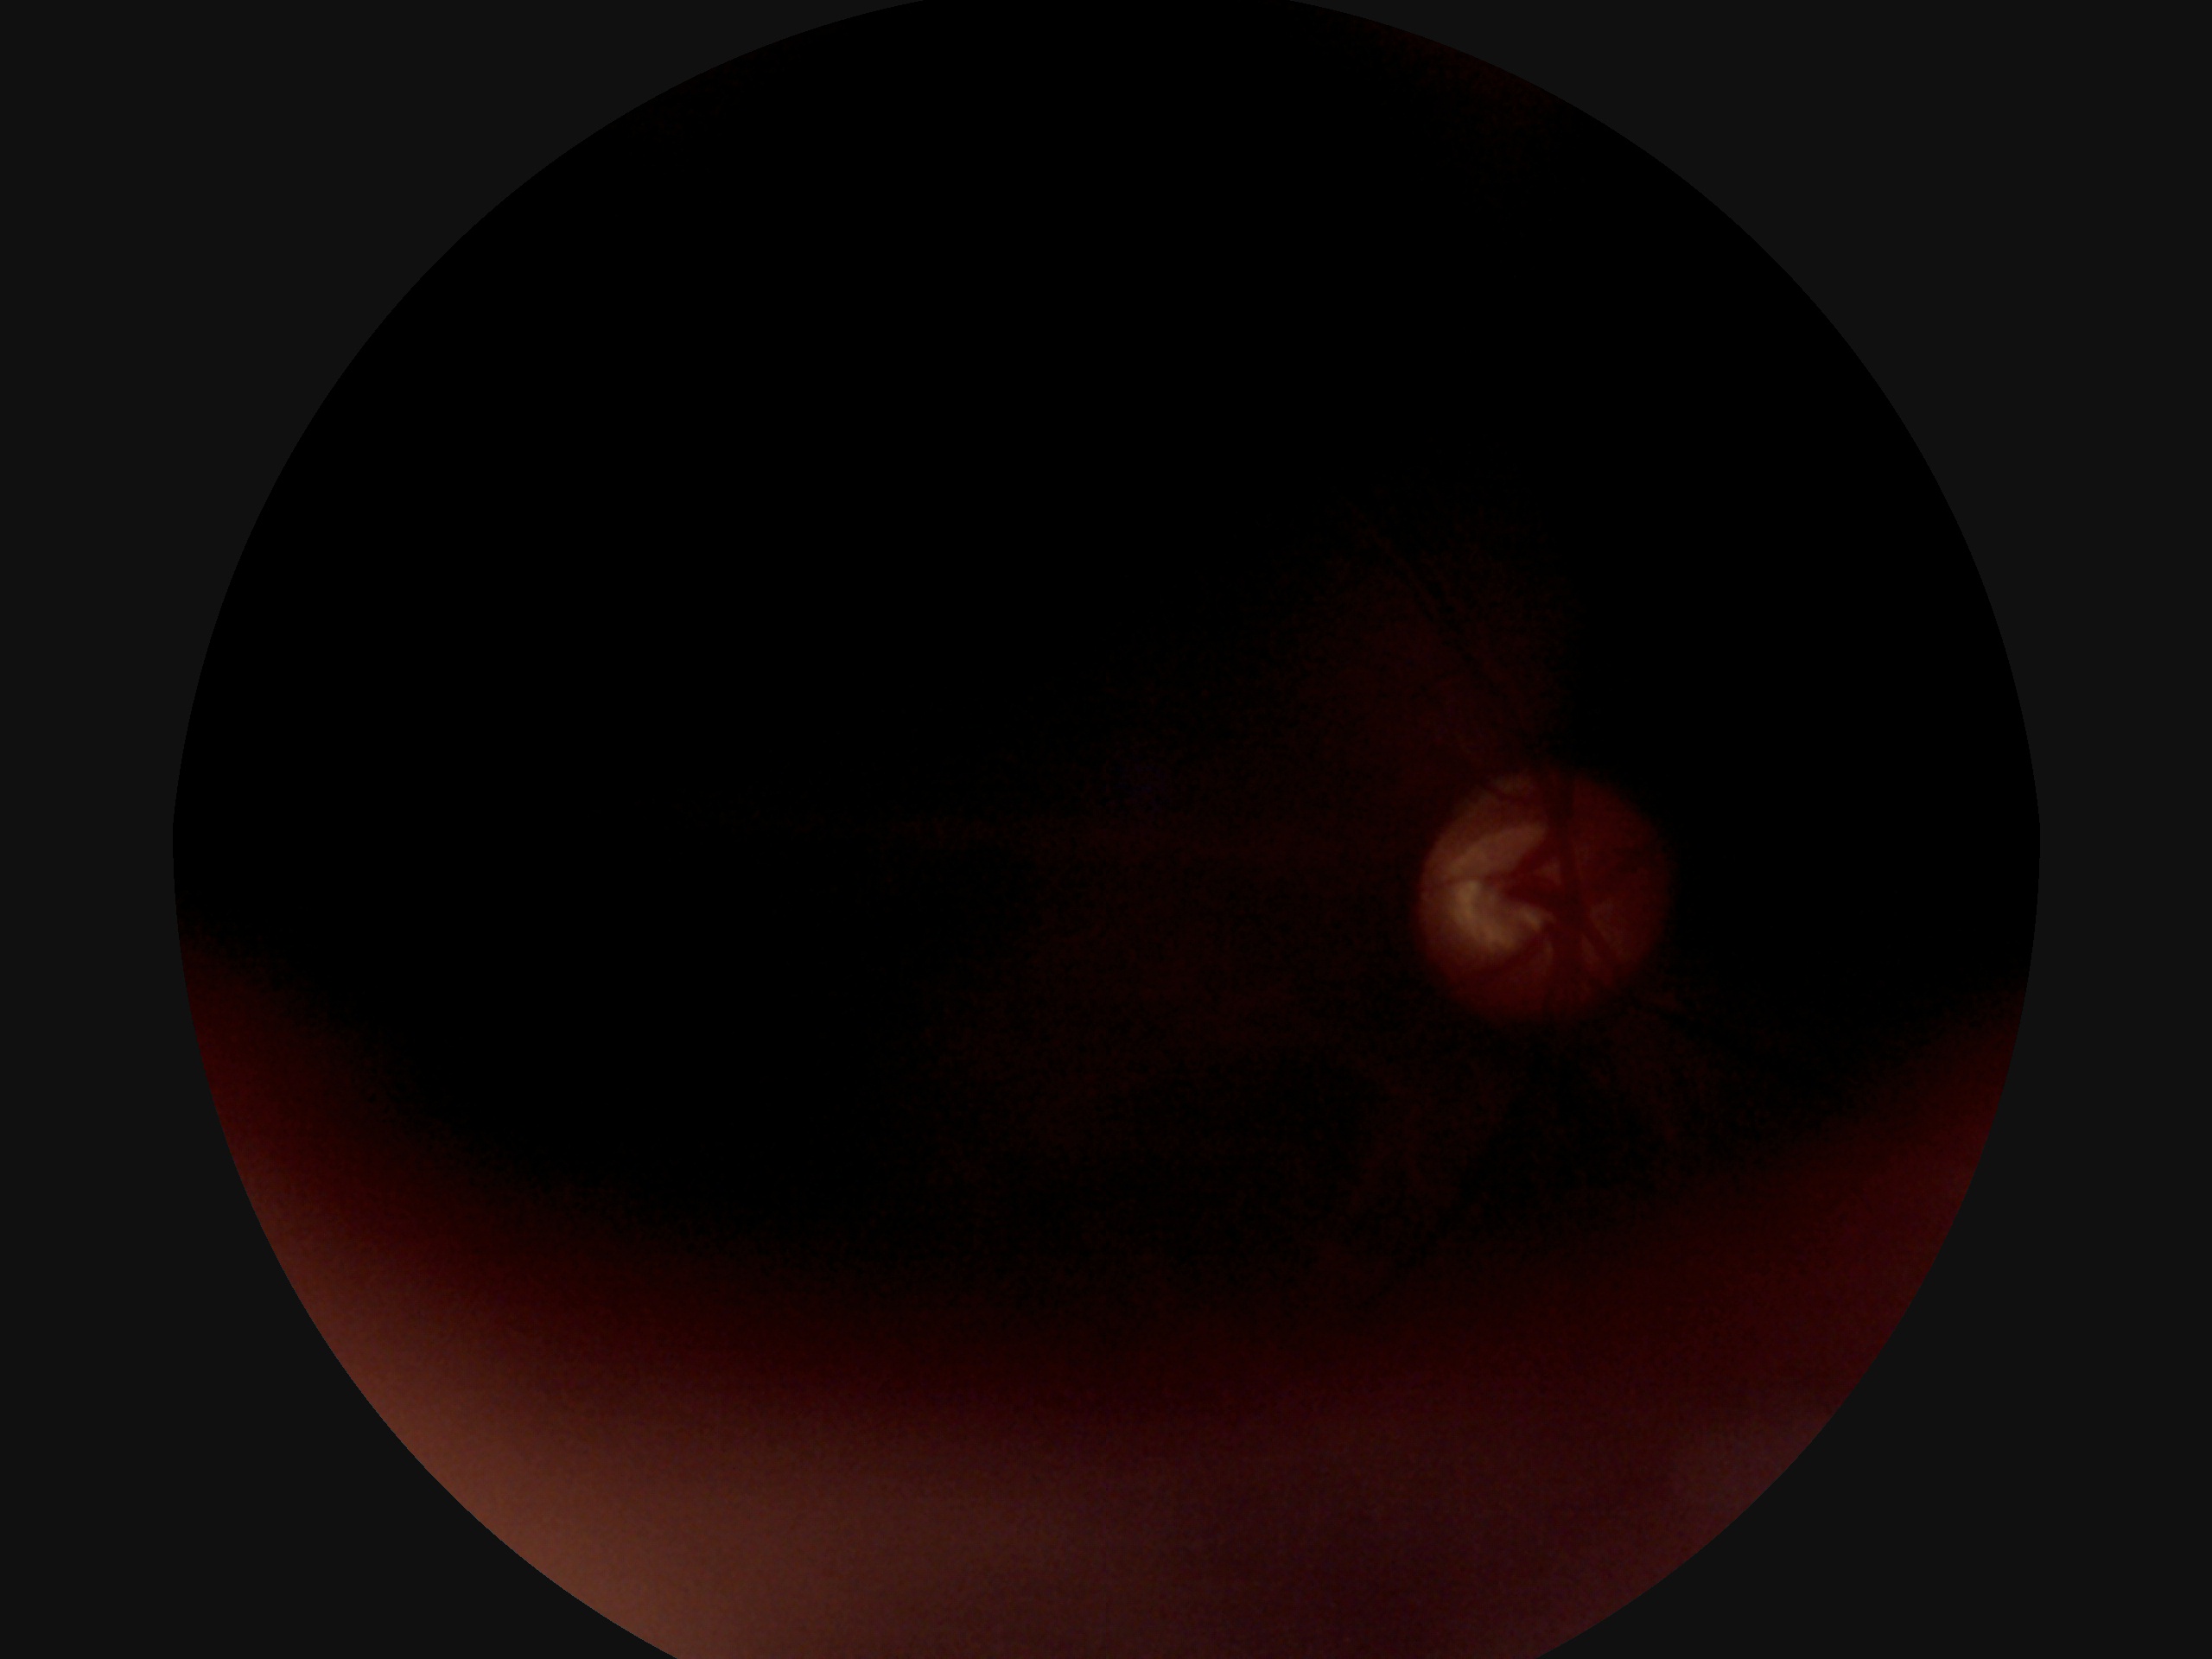 DR severity: ungradable.